Color fundus photograph; 45° field of view.
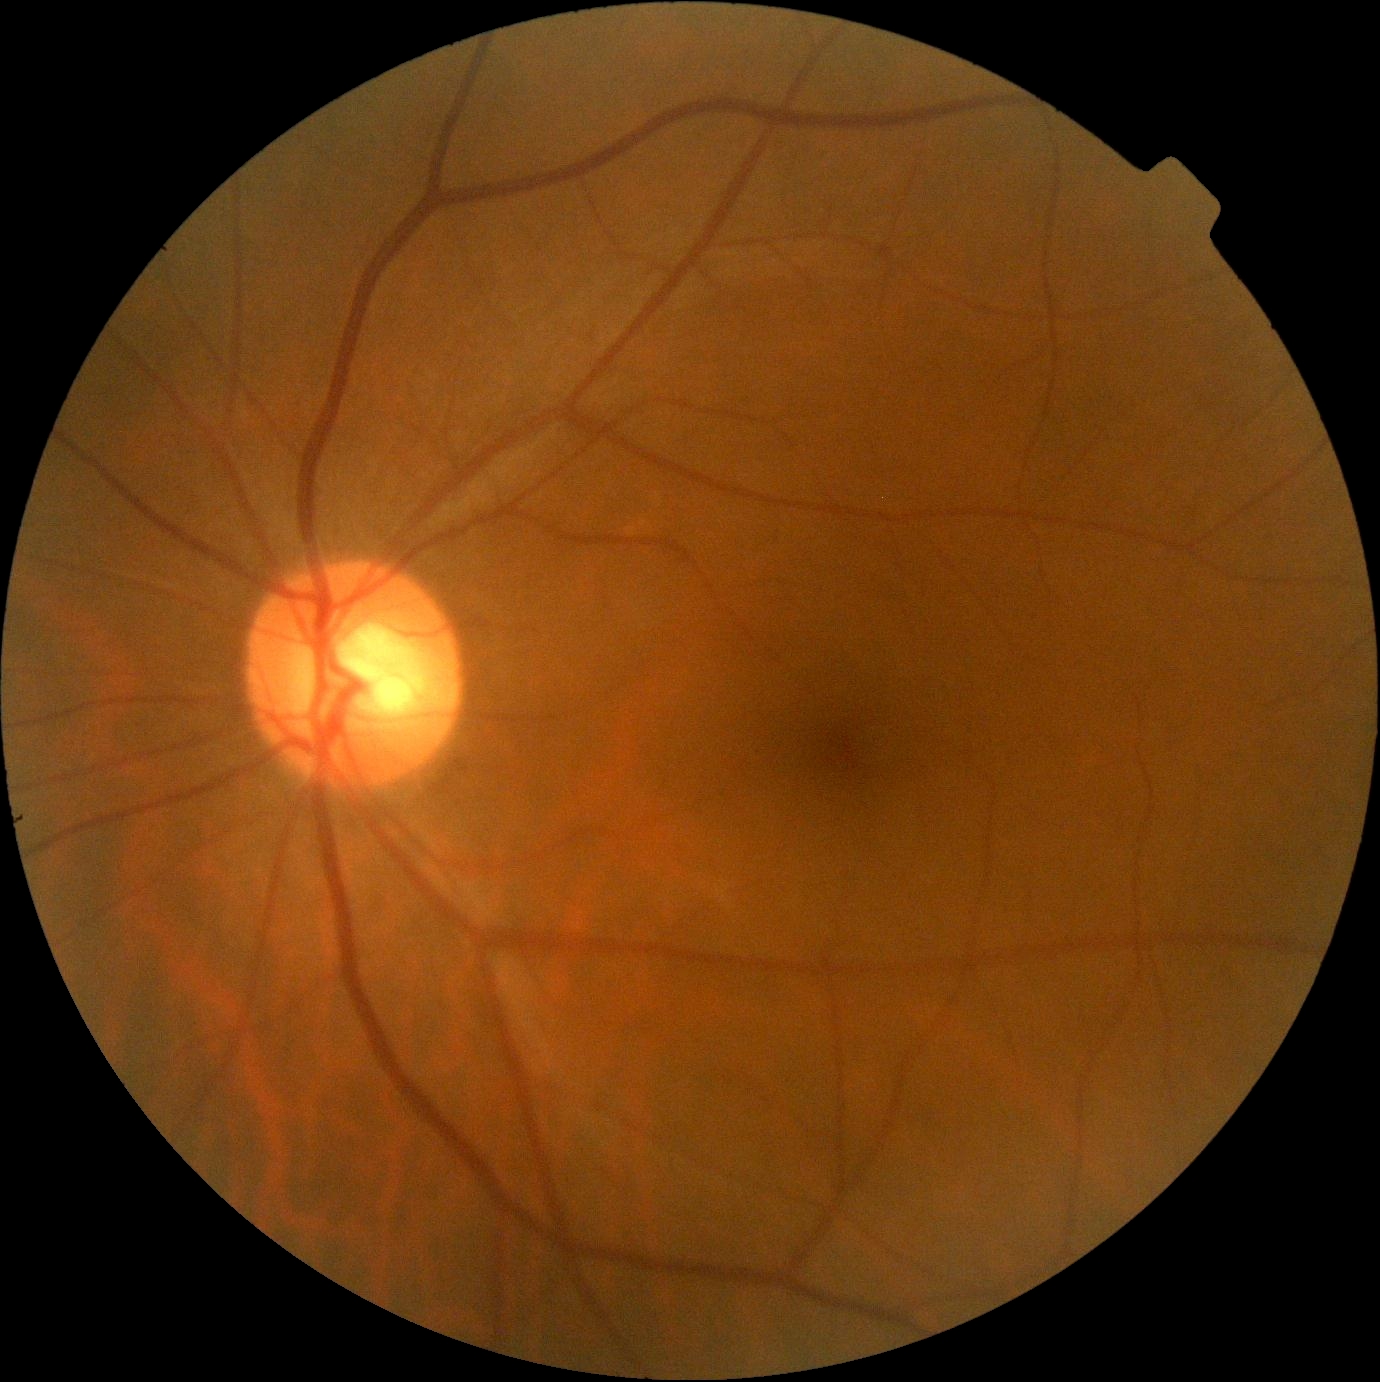 DR stage is grade 0 (no apparent retinopathy).